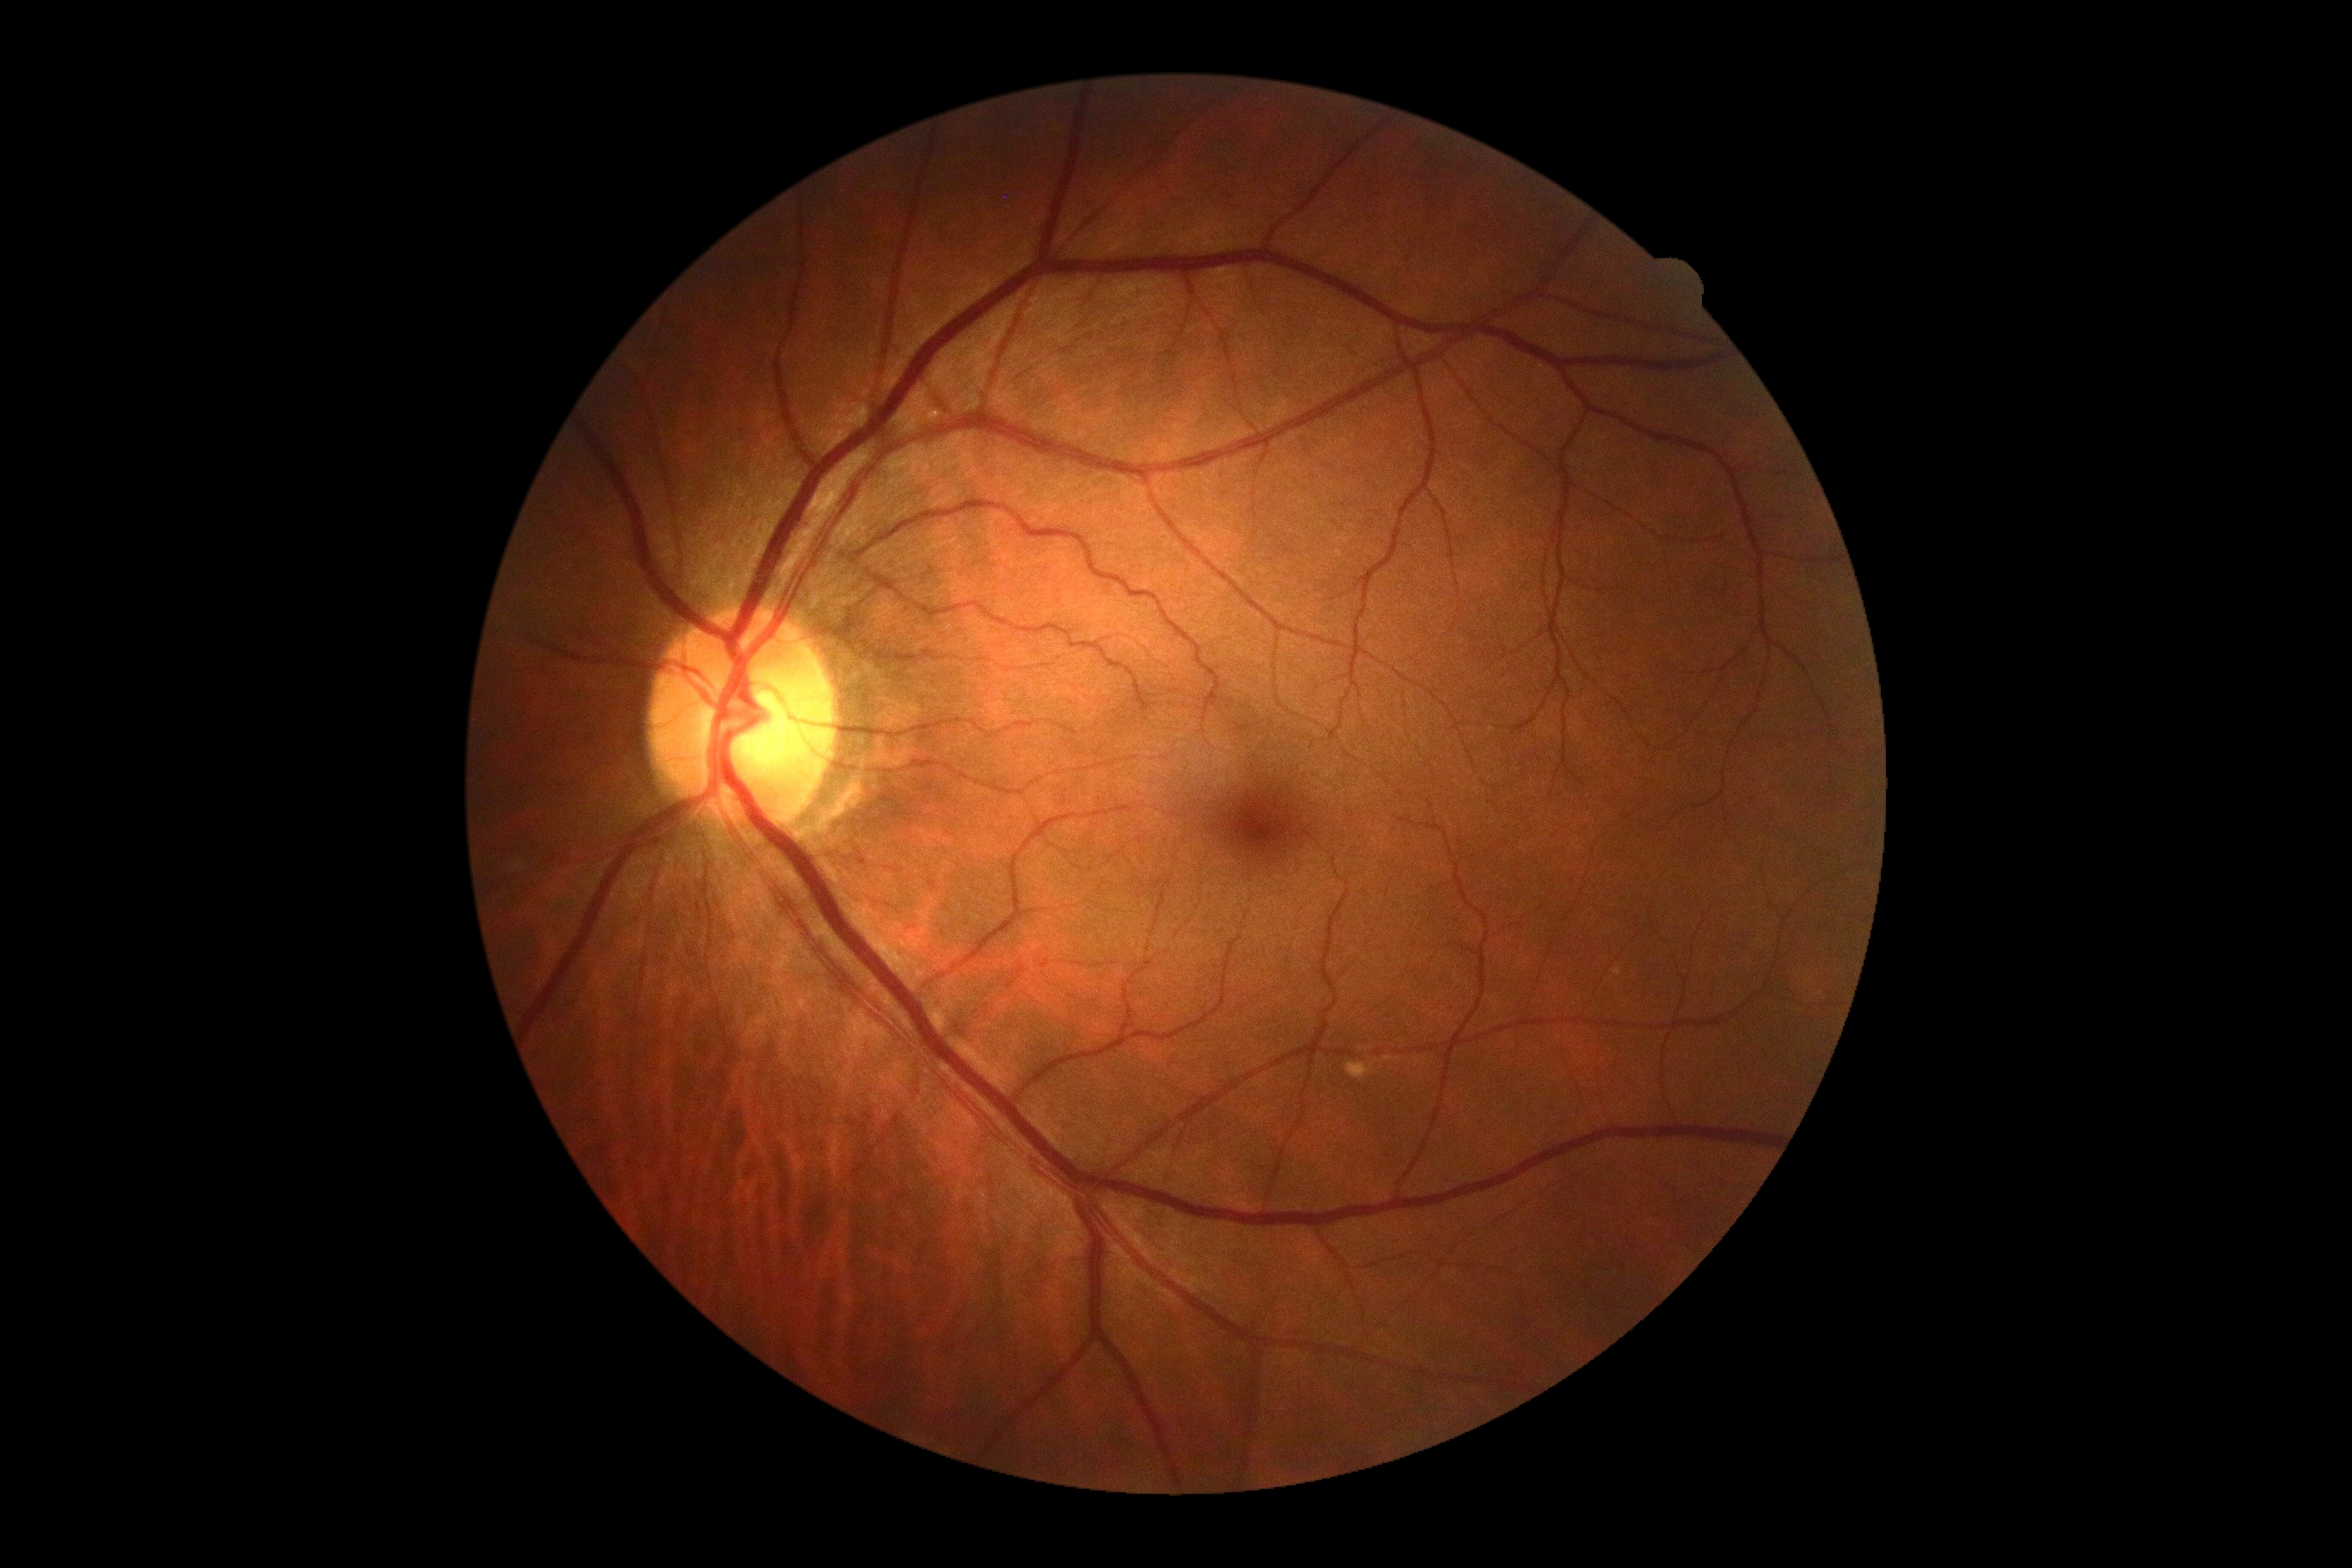

DR grade is 0. No diabetic retinal disease findings.